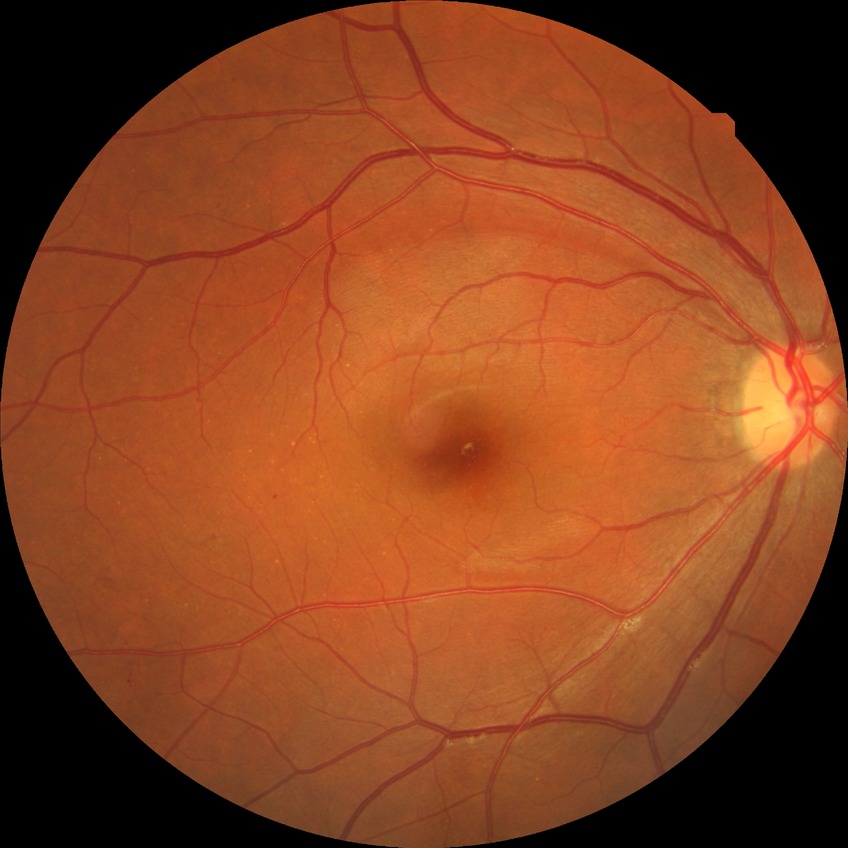 Retinopathy stage: simple diabetic retinopathy.